Fundus image cropped to the optic disc, Topcon TRC retinal camera, IMAGEnet capture system, 367 x 367 pixels — 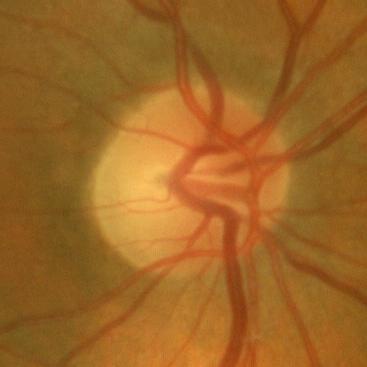

Optic disc appearance consistent with no glaucomatous findings.